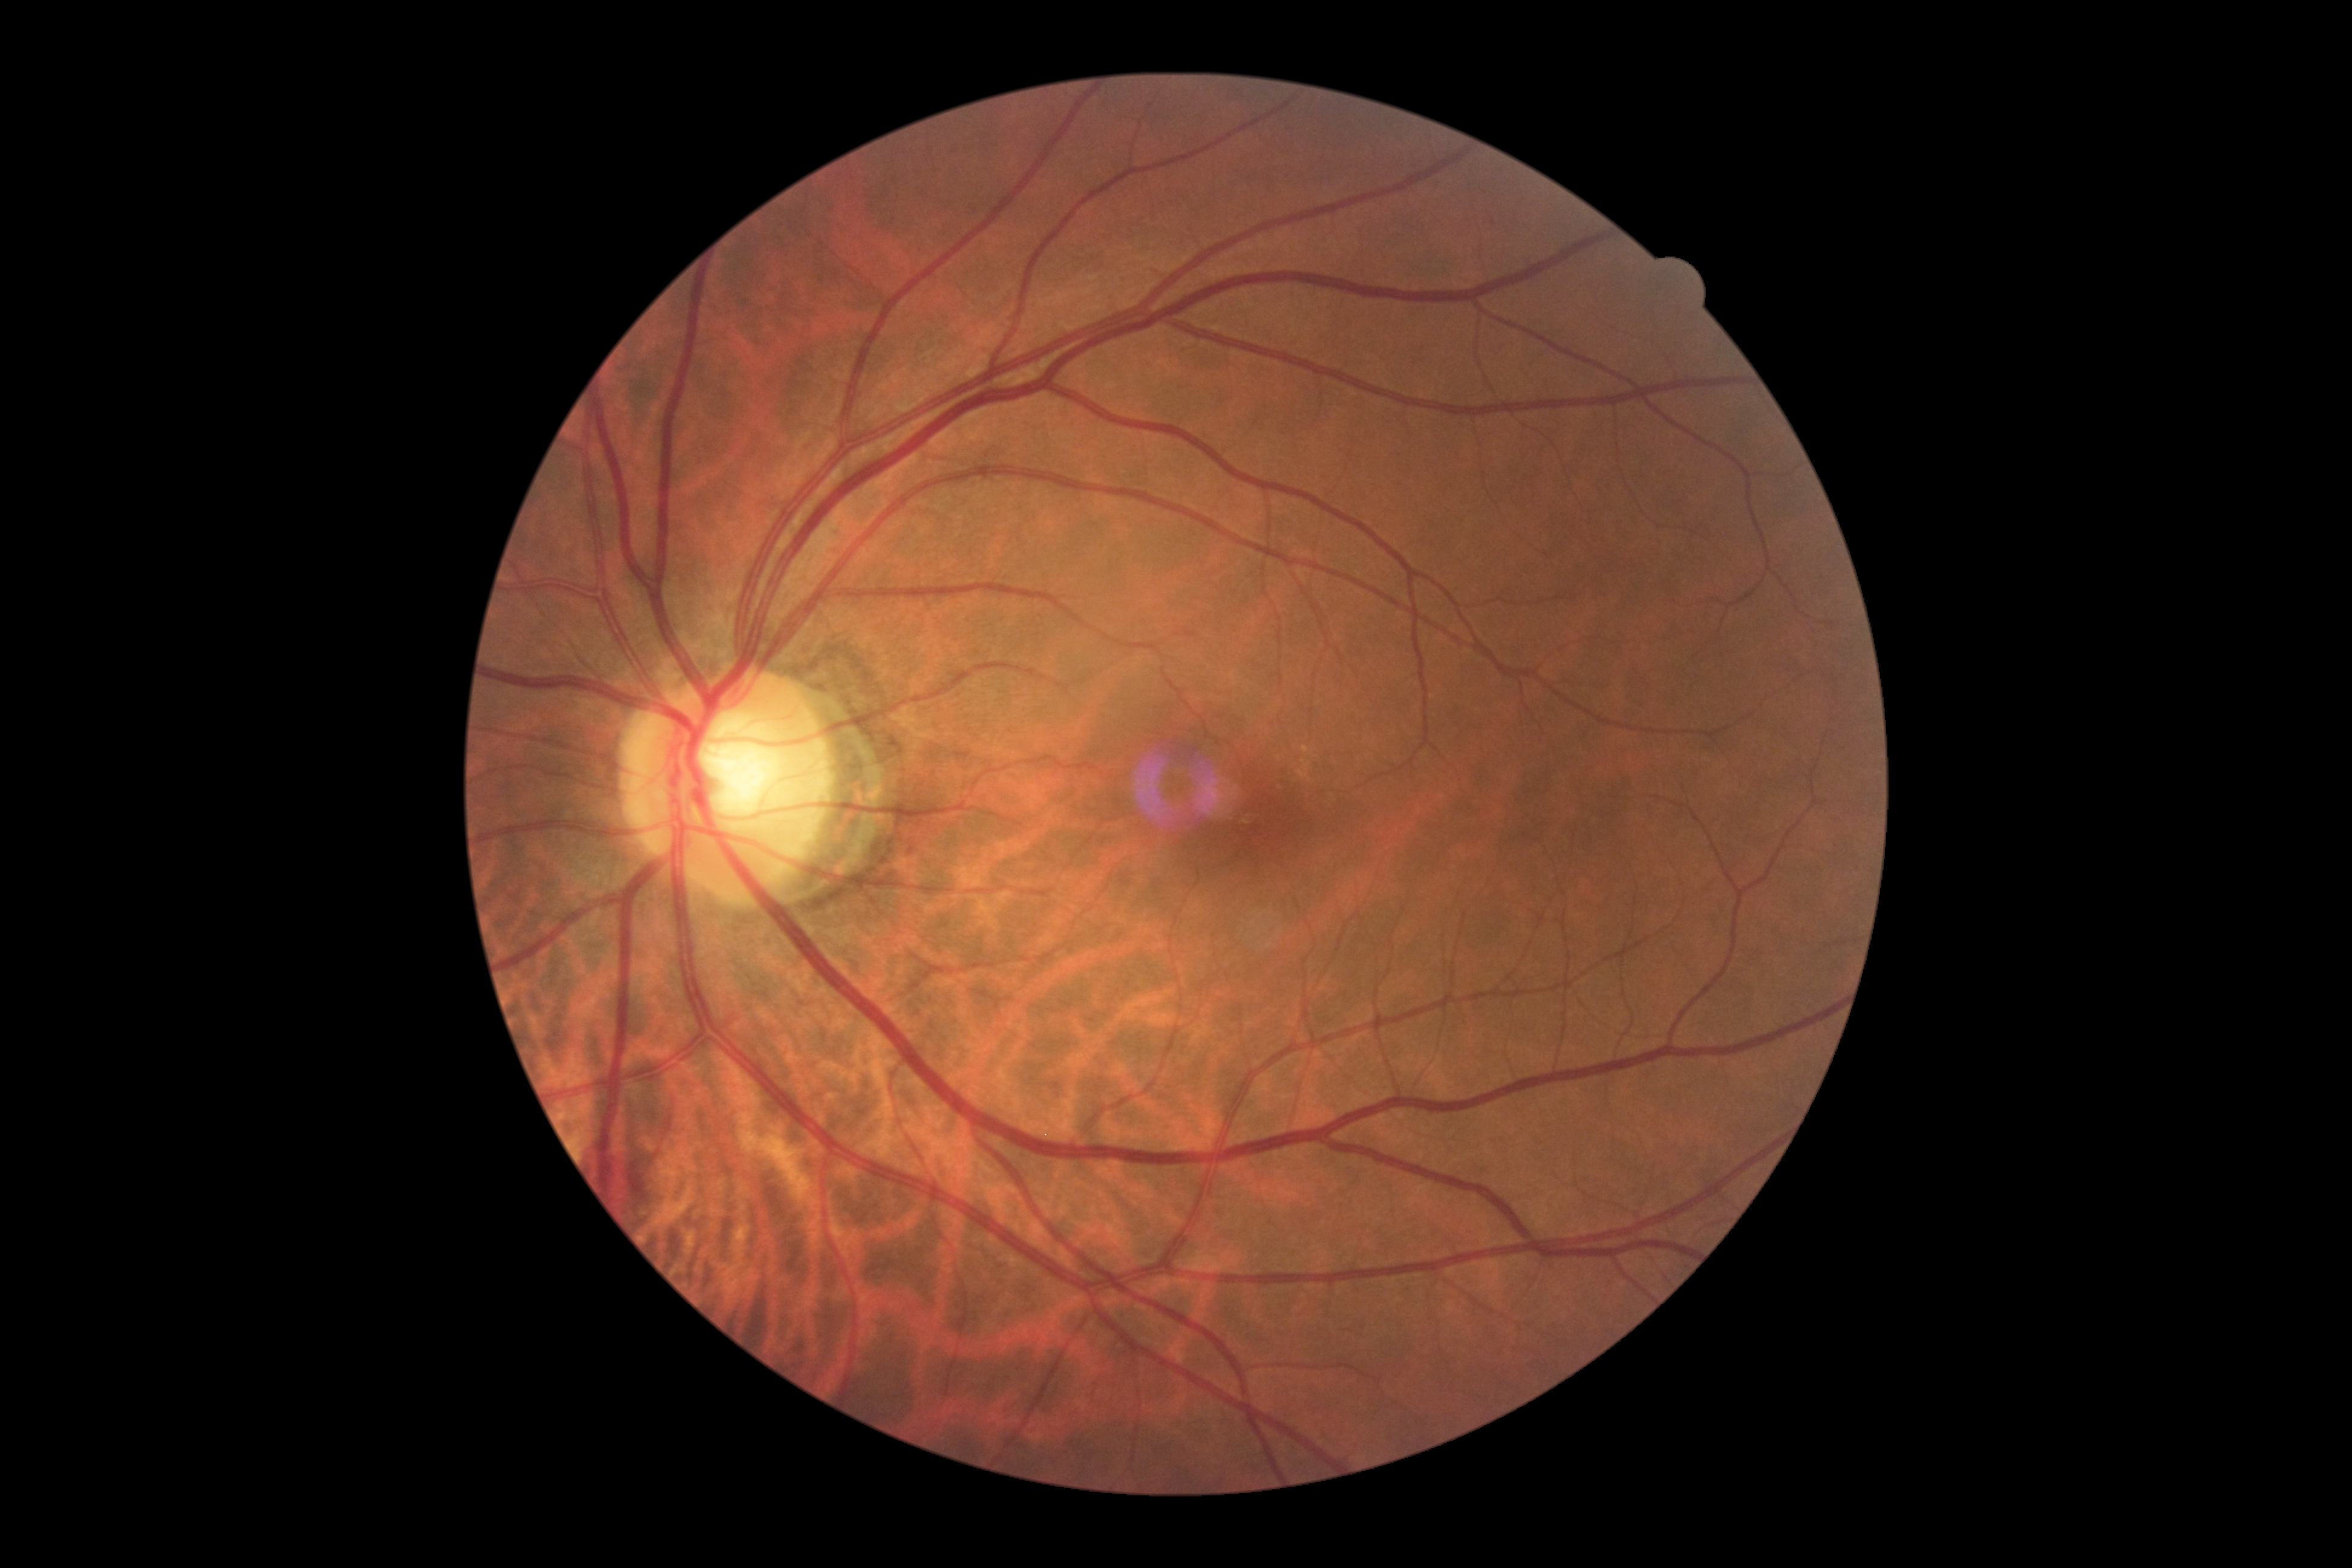
Retinopathy is grade 2 (moderate NPDR).